45° field of view; color fundus image.
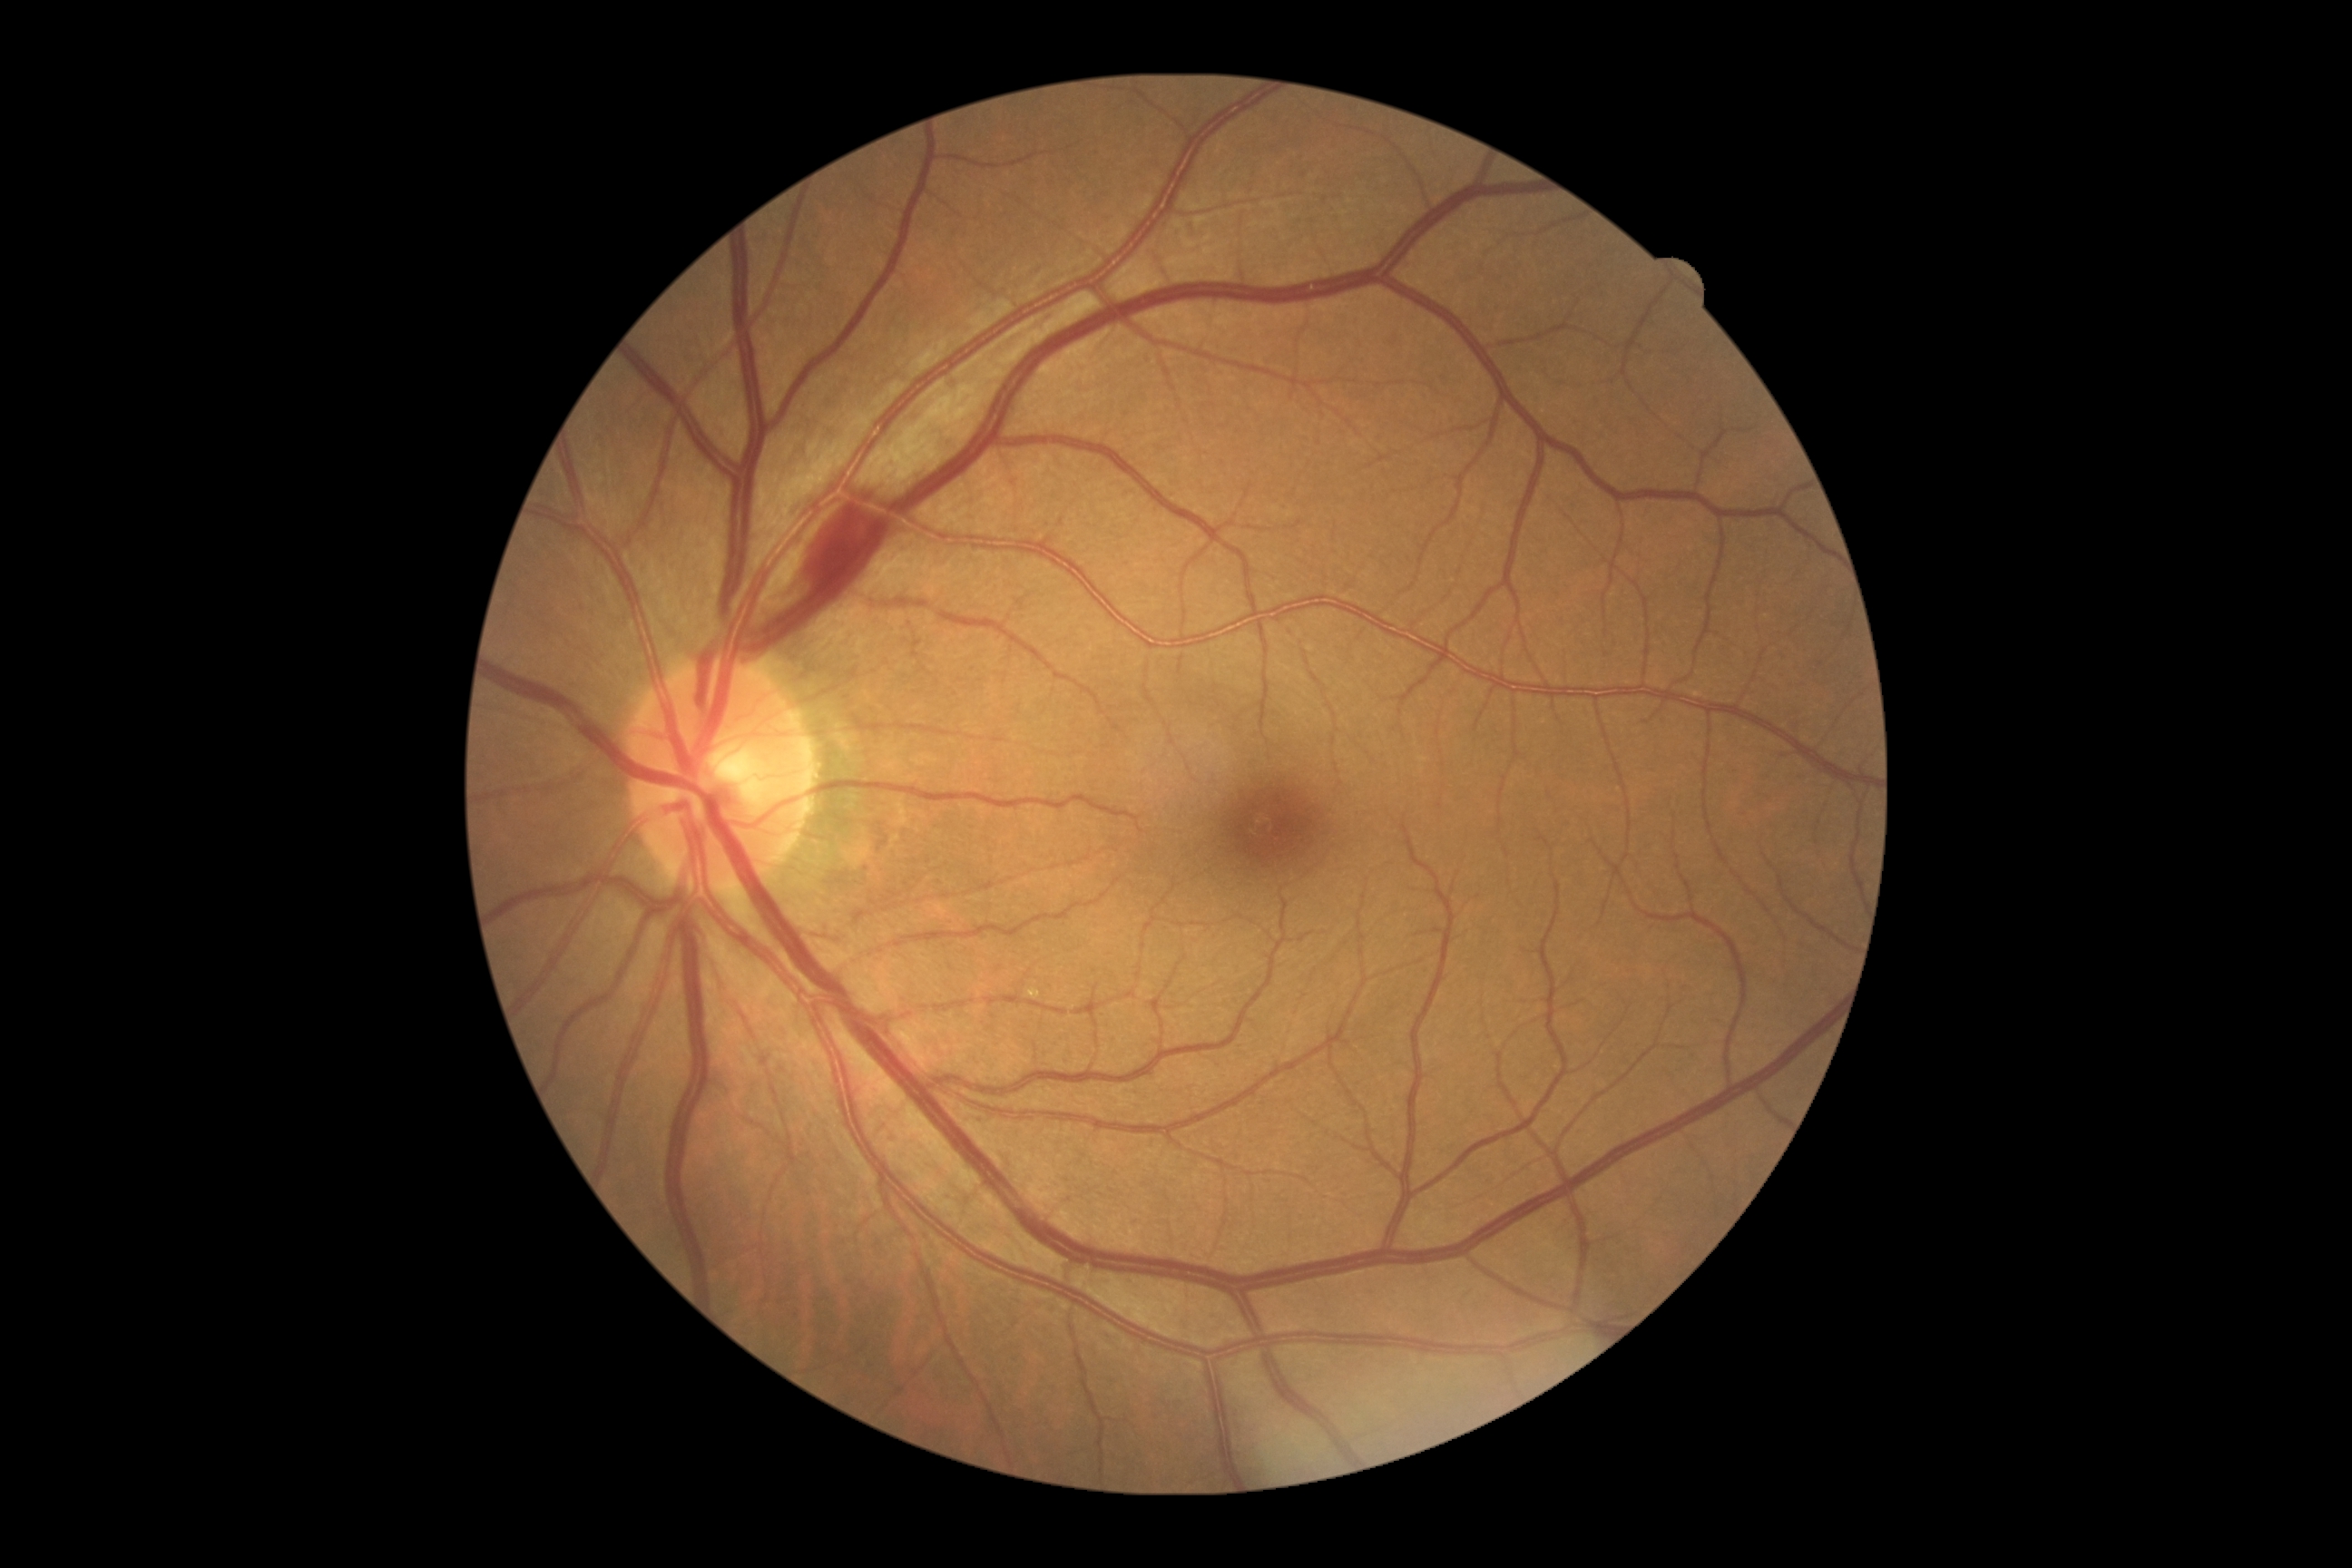

DR stage = grade 2 | DR class = non-proliferative diabetic retinopathy.